Camera: Nidek AFC-330: 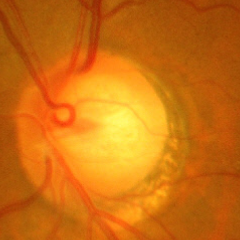

Fundus image with findings of advanced-stage glaucoma. (Criteria: near-total cupping of the optic nerve head, with or without severe visual field loss within the central 10 degrees of fixation.)